Camera: Phoenix ICON (100° FOV); wide-field fundus photograph from neonatal ROP screening: 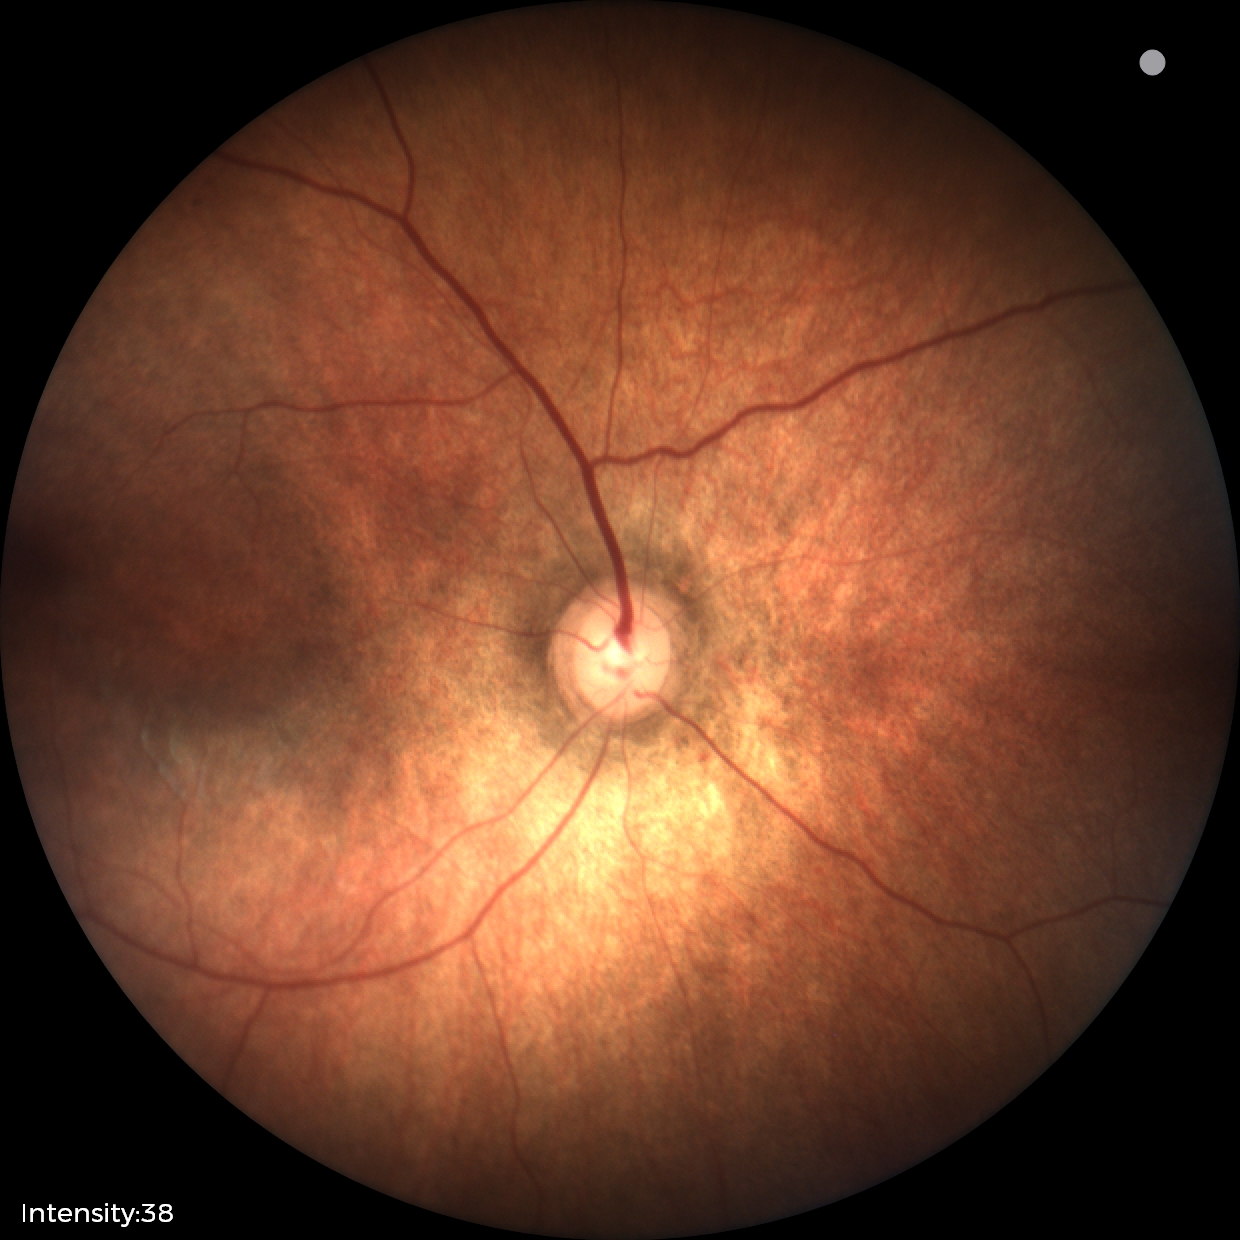

Normal screening examination.